Color fundus photograph.
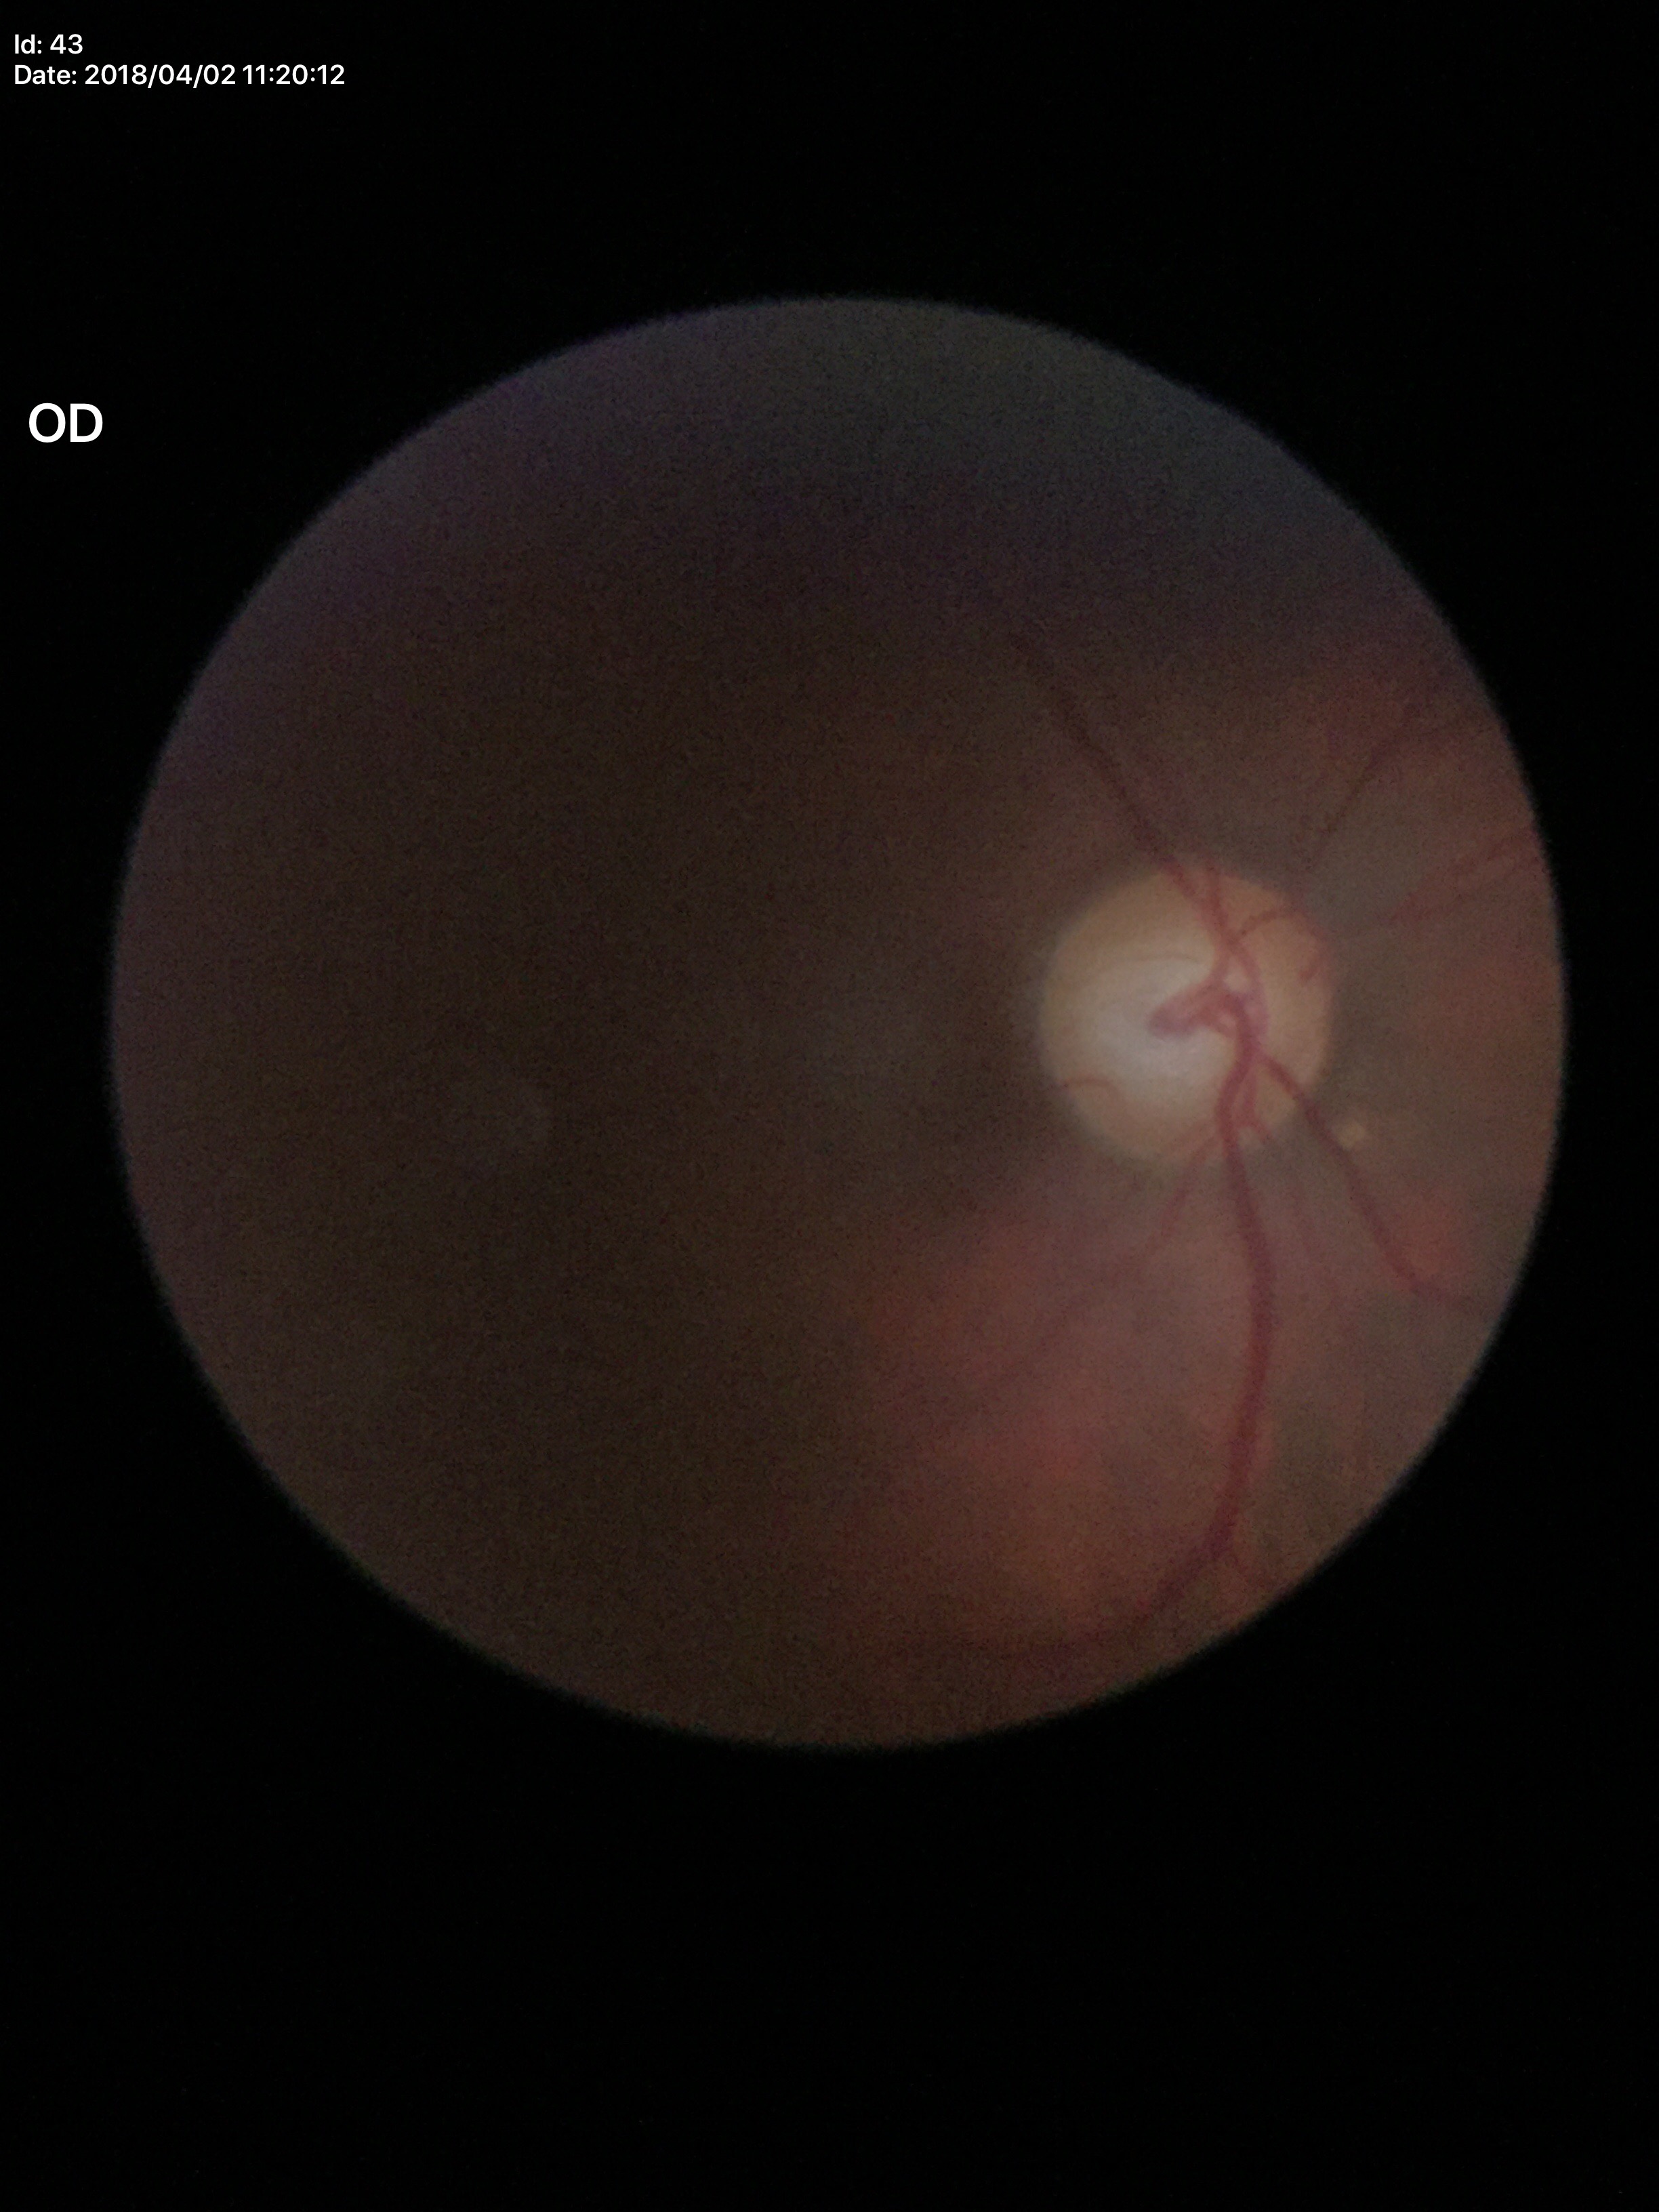 Optic disc analysis:
* Glaucoma screening impression · suspicious findings (4/5 graders called glaucoma suspect)
* vertical cup-to-disc ratio · 0.63
* horizontal C/D ratio · 0.67